NIDEK AFC-230 fundus camera · 45 degree fundus photograph · without pupil dilation · image size 848x848 · posterior pole color fundus photograph.
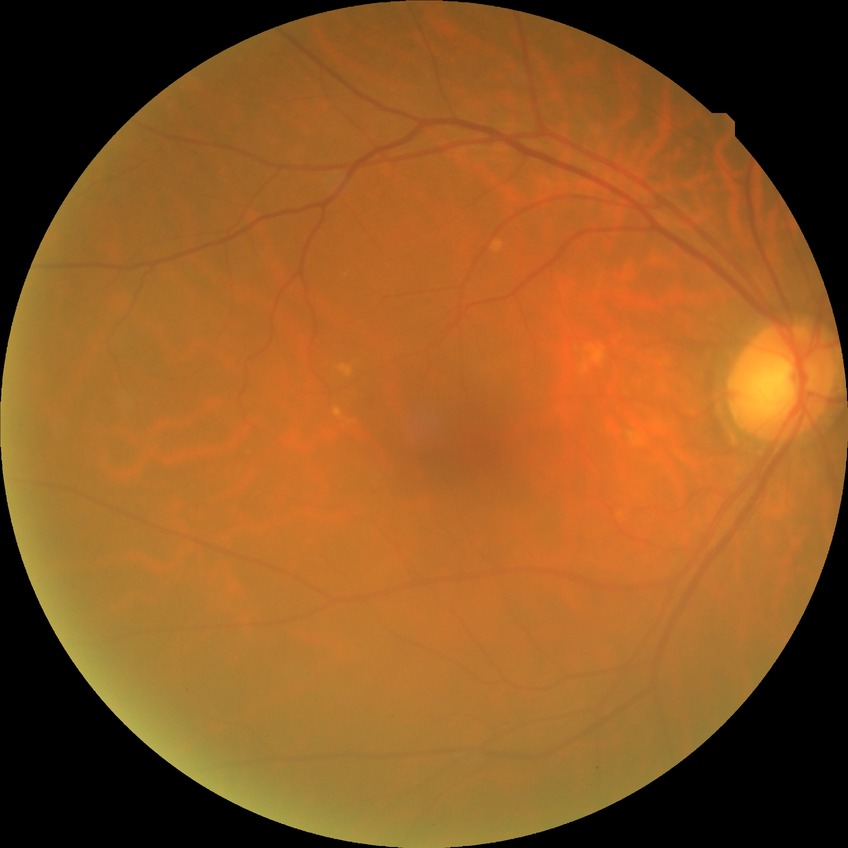
Davis DR grade is NDR.